Acquired with a Topcon TRC, optic disc region of a color fundus photo.
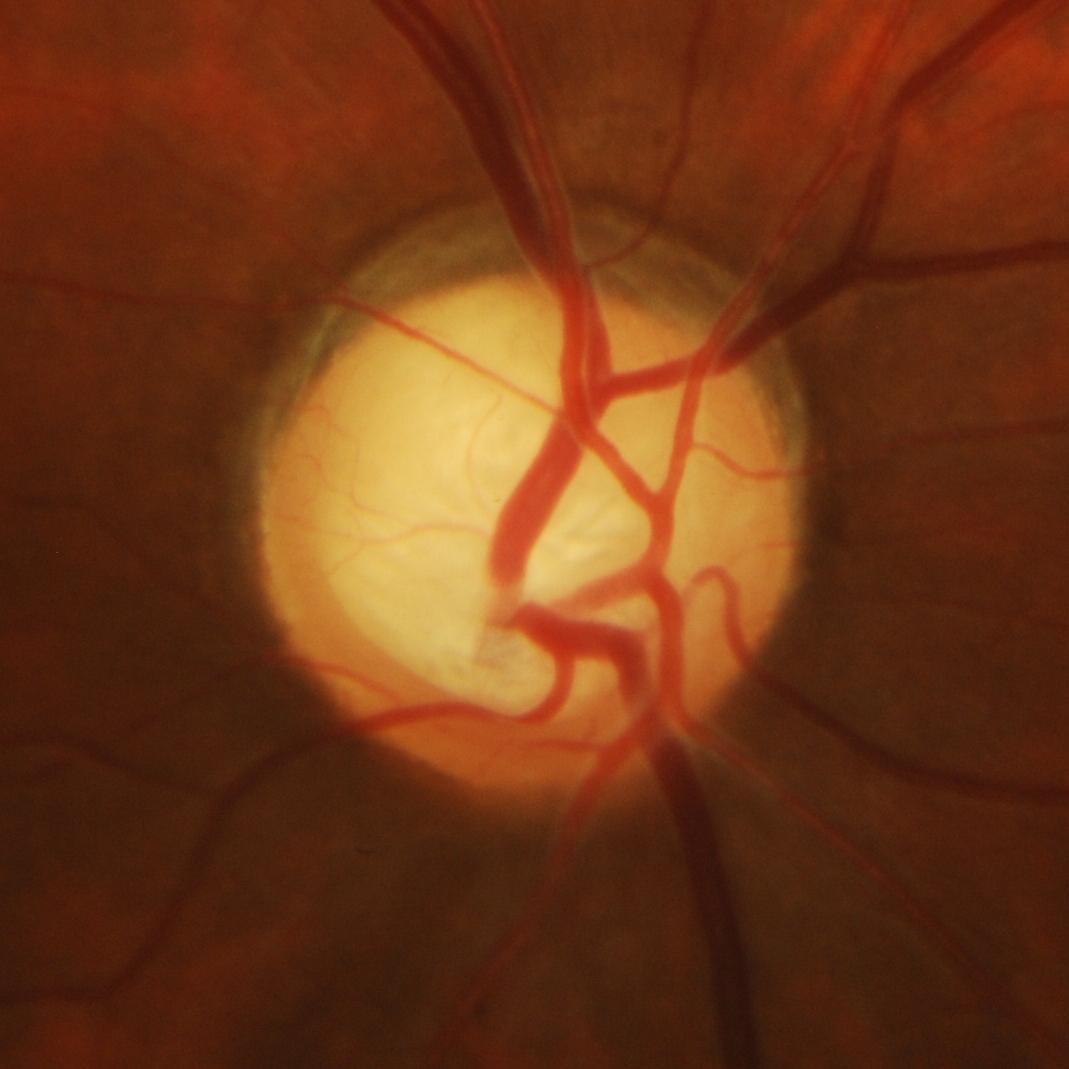

There is evidence of glaucomatous findings.